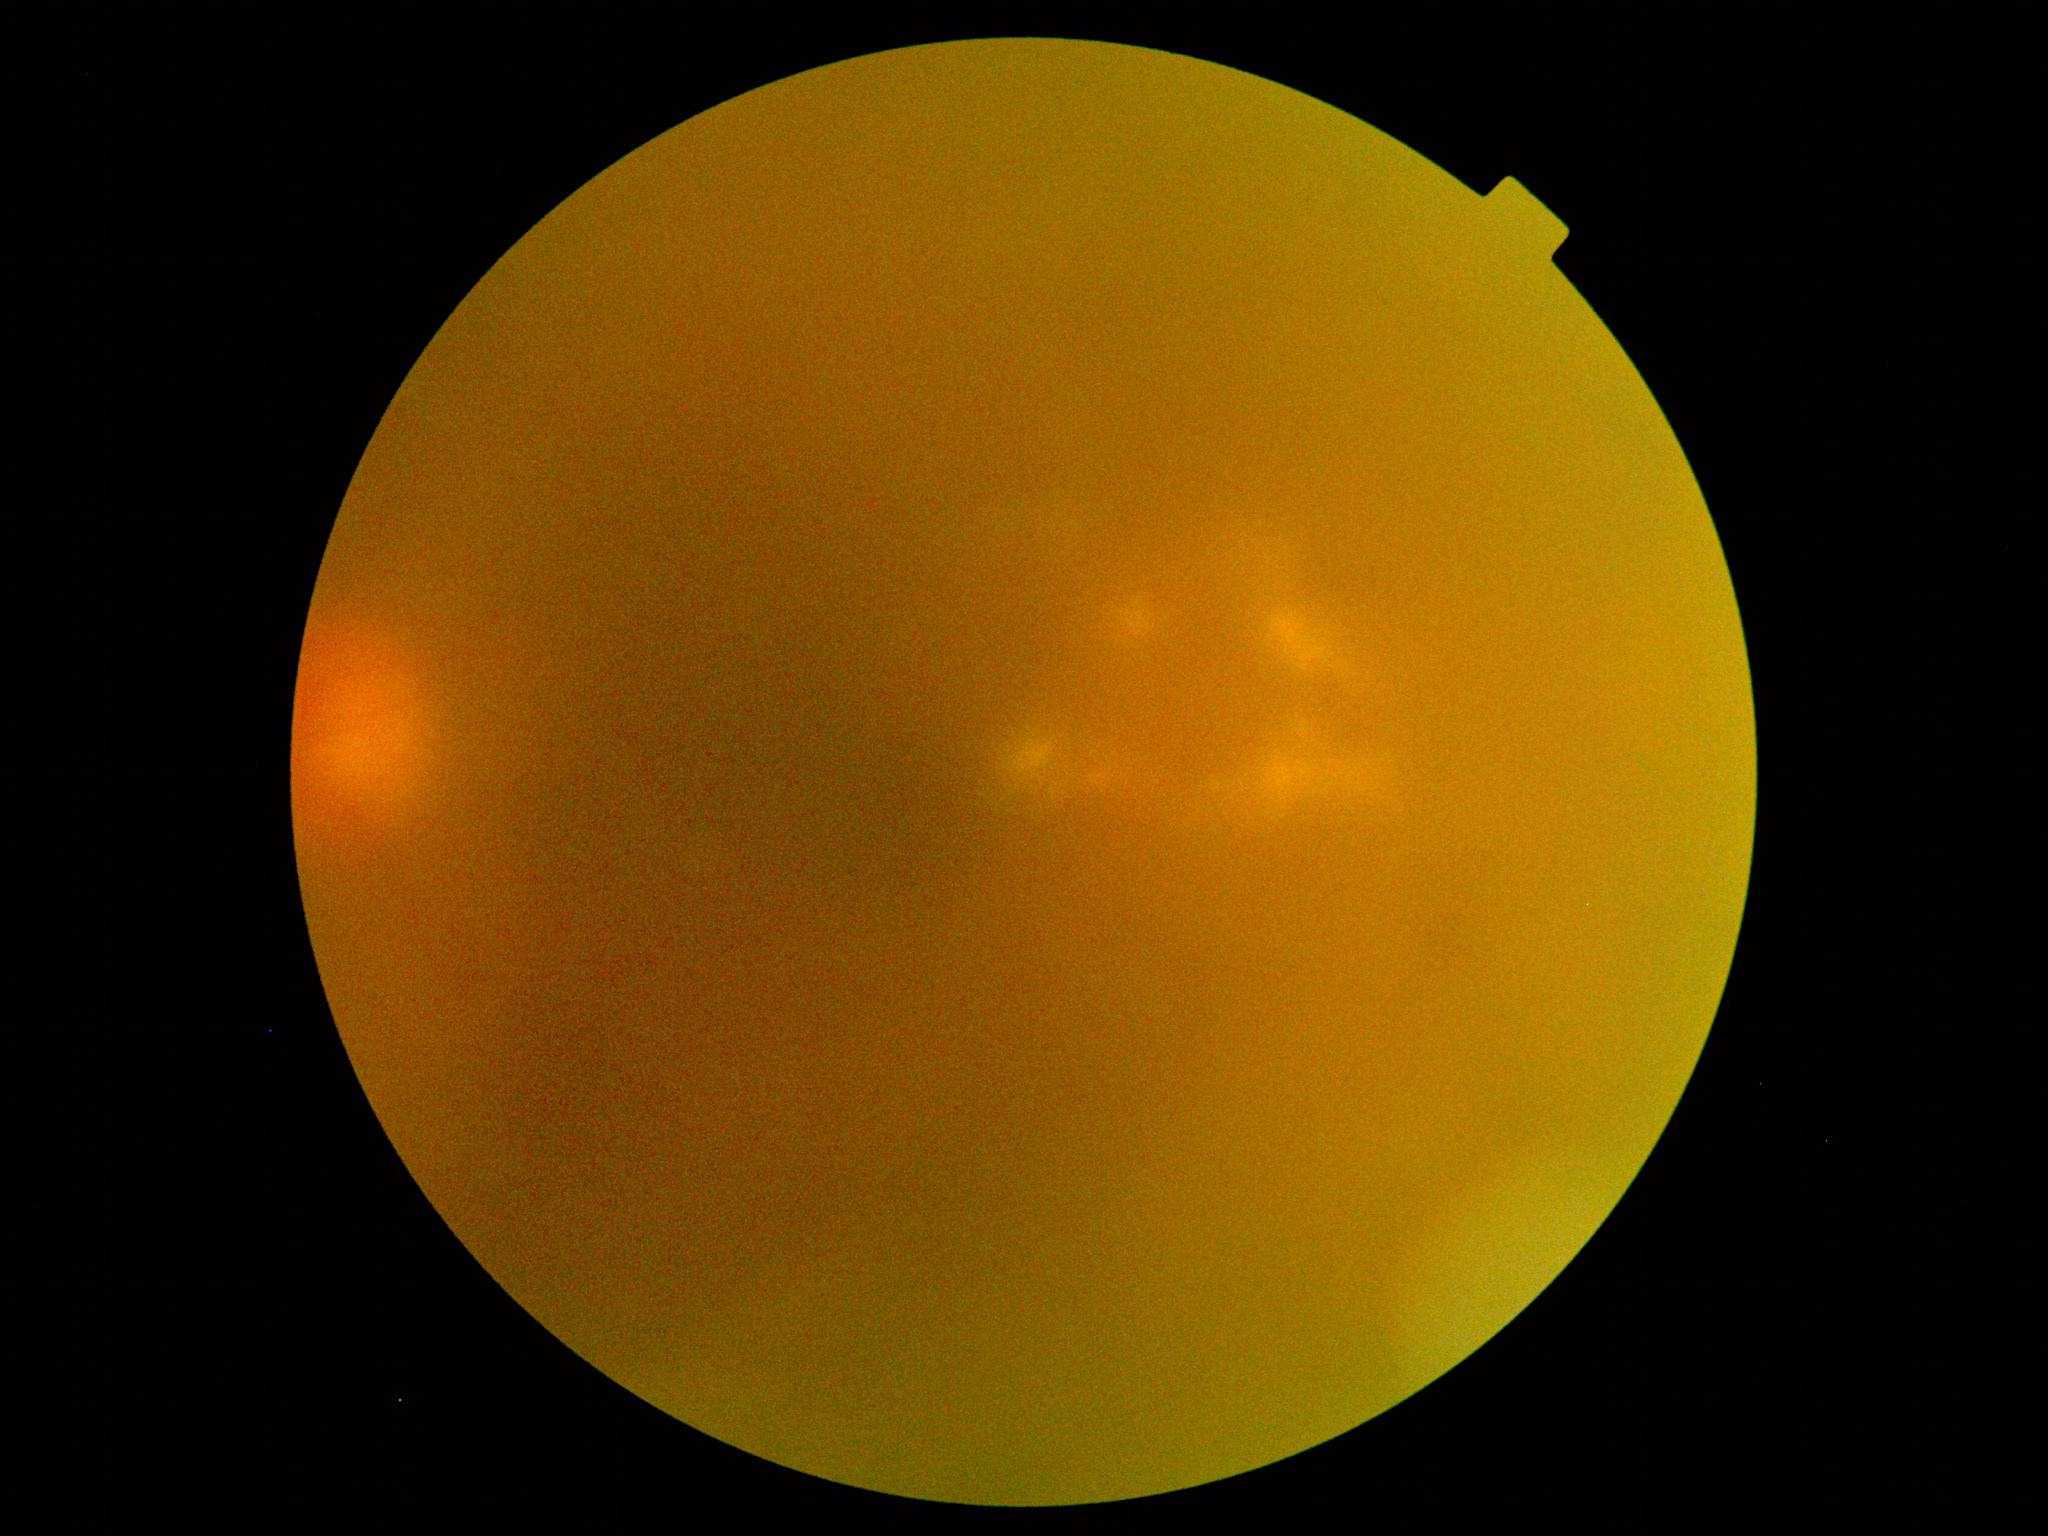

– retinopathy grade: moderate non-proliferative diabetic retinopathy (2)